Refraction: +3.25 -0.25 x 83; 61-year-old patient; woman patient:
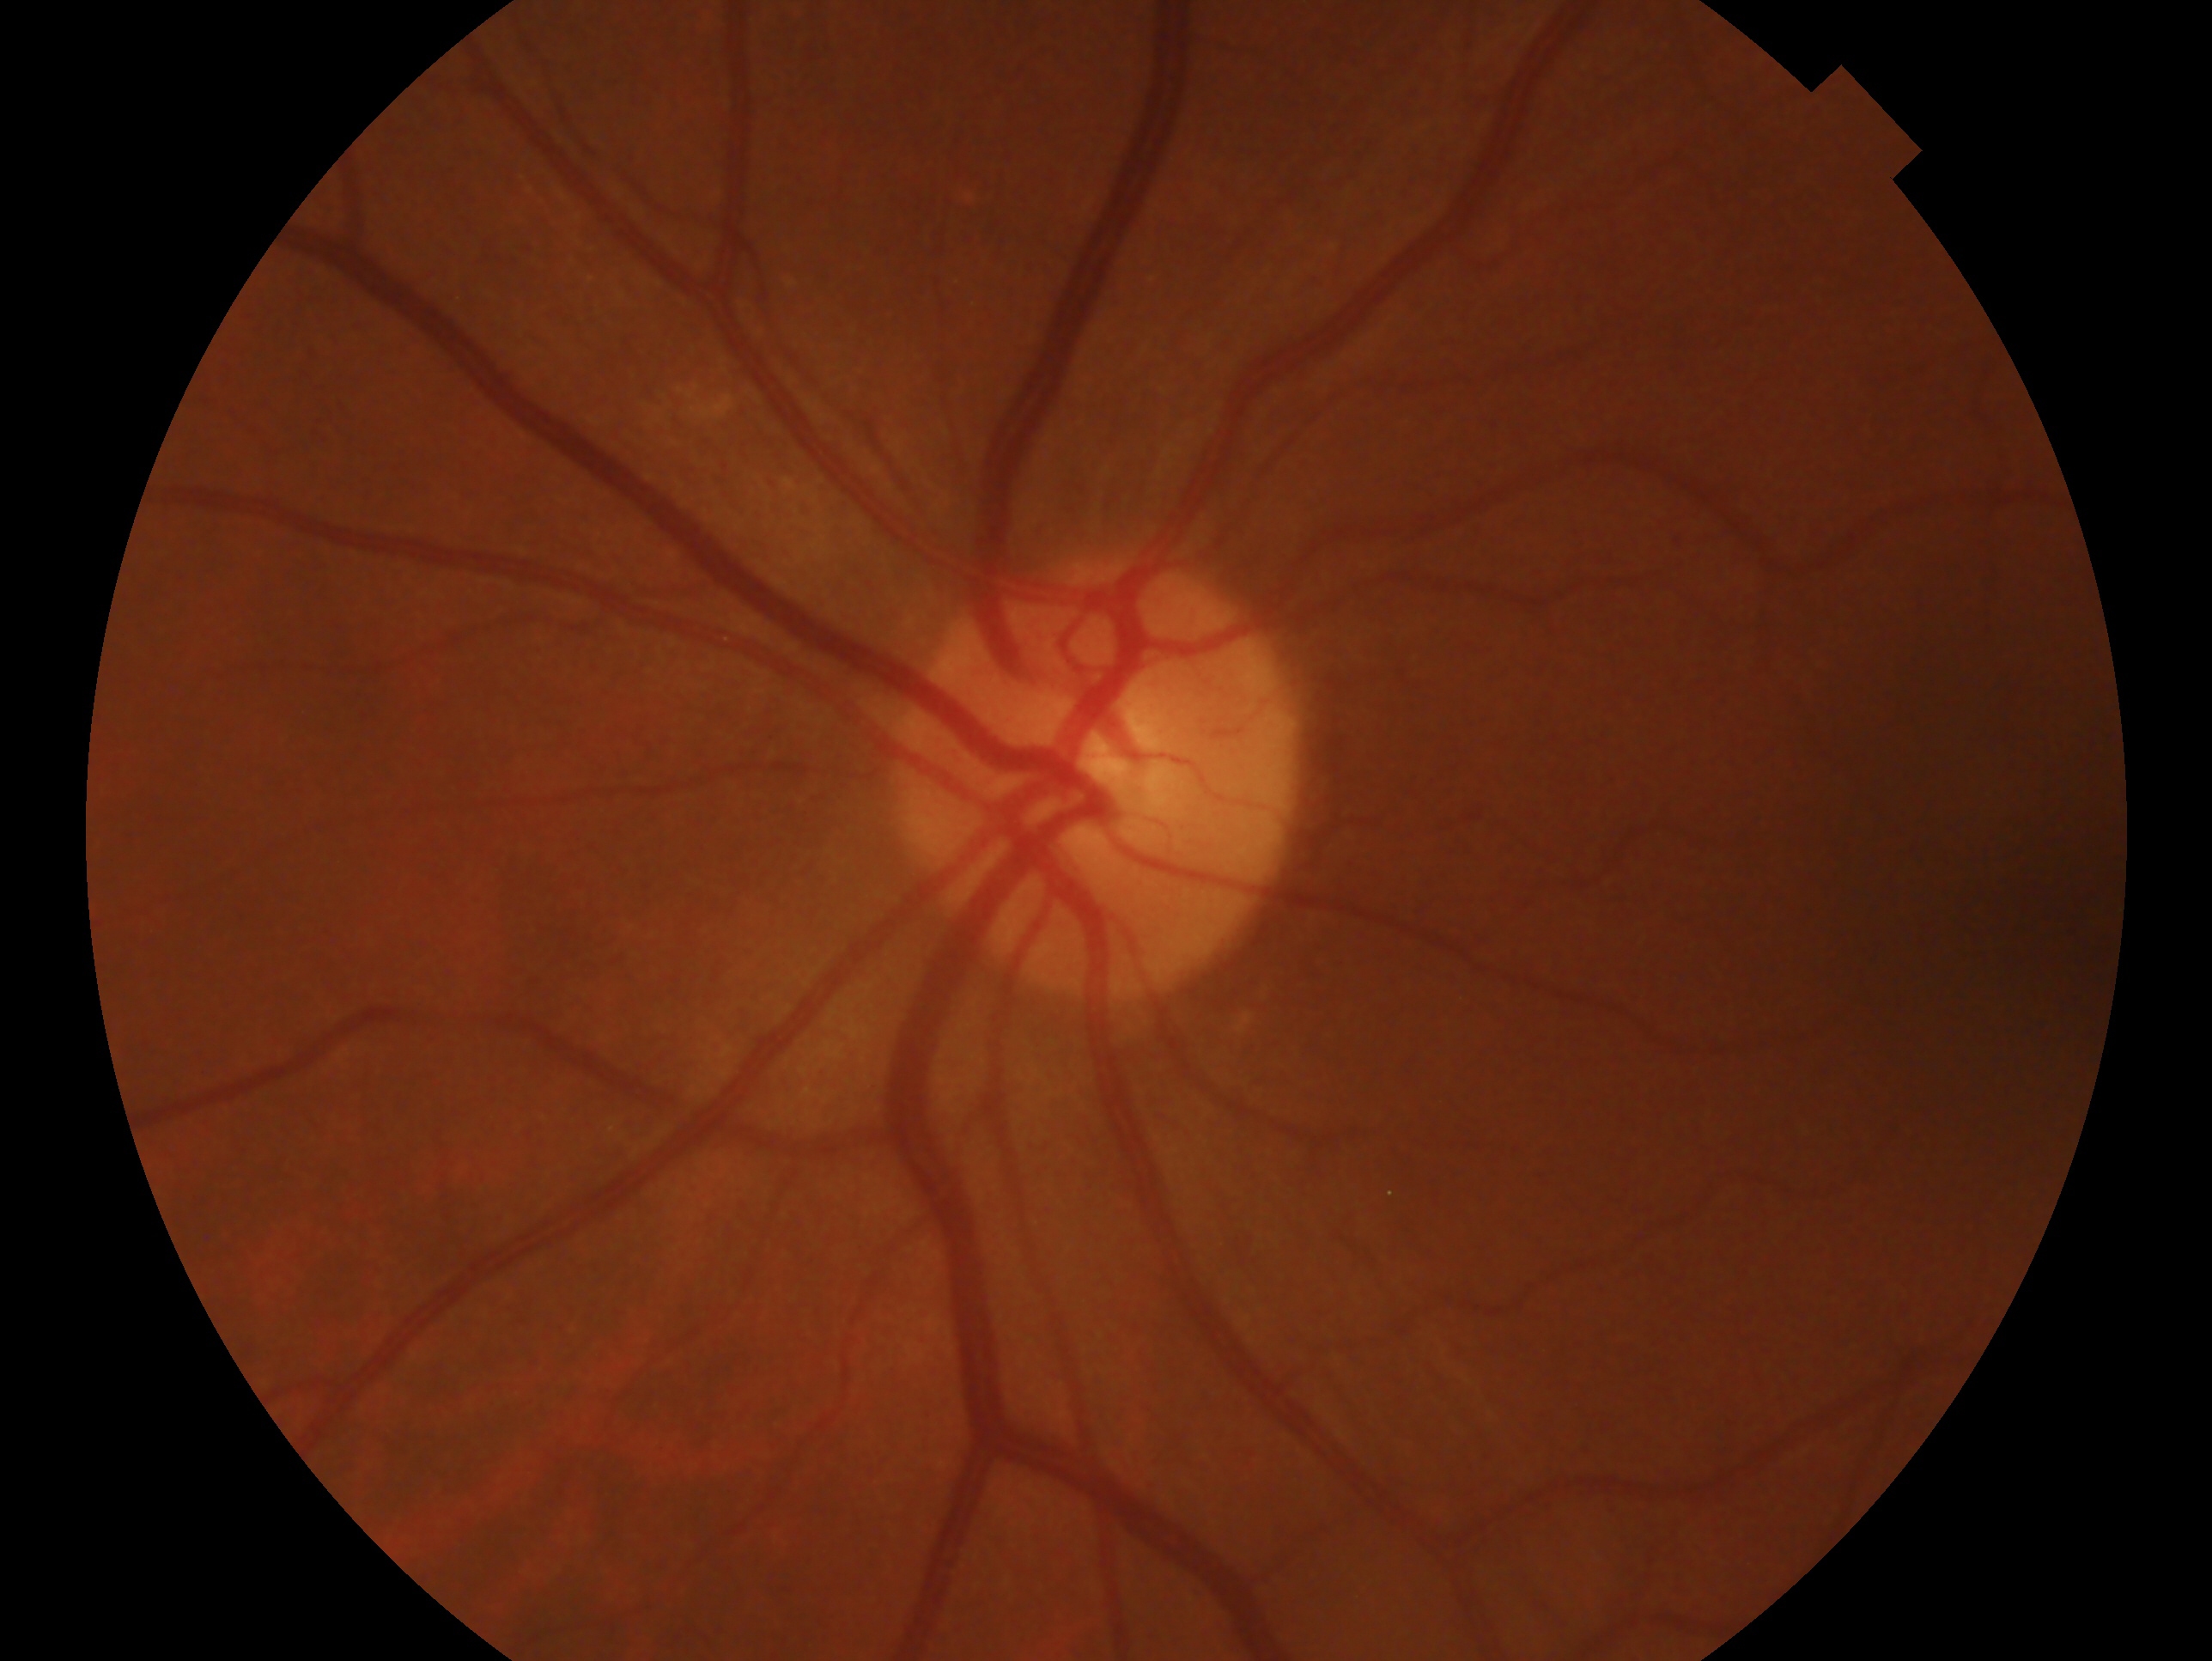

  glaucoma_dx: negative for glaucoma — no clinical evidence of glaucoma in this eye
  eye: OS